2212x1659. Fundus photo — 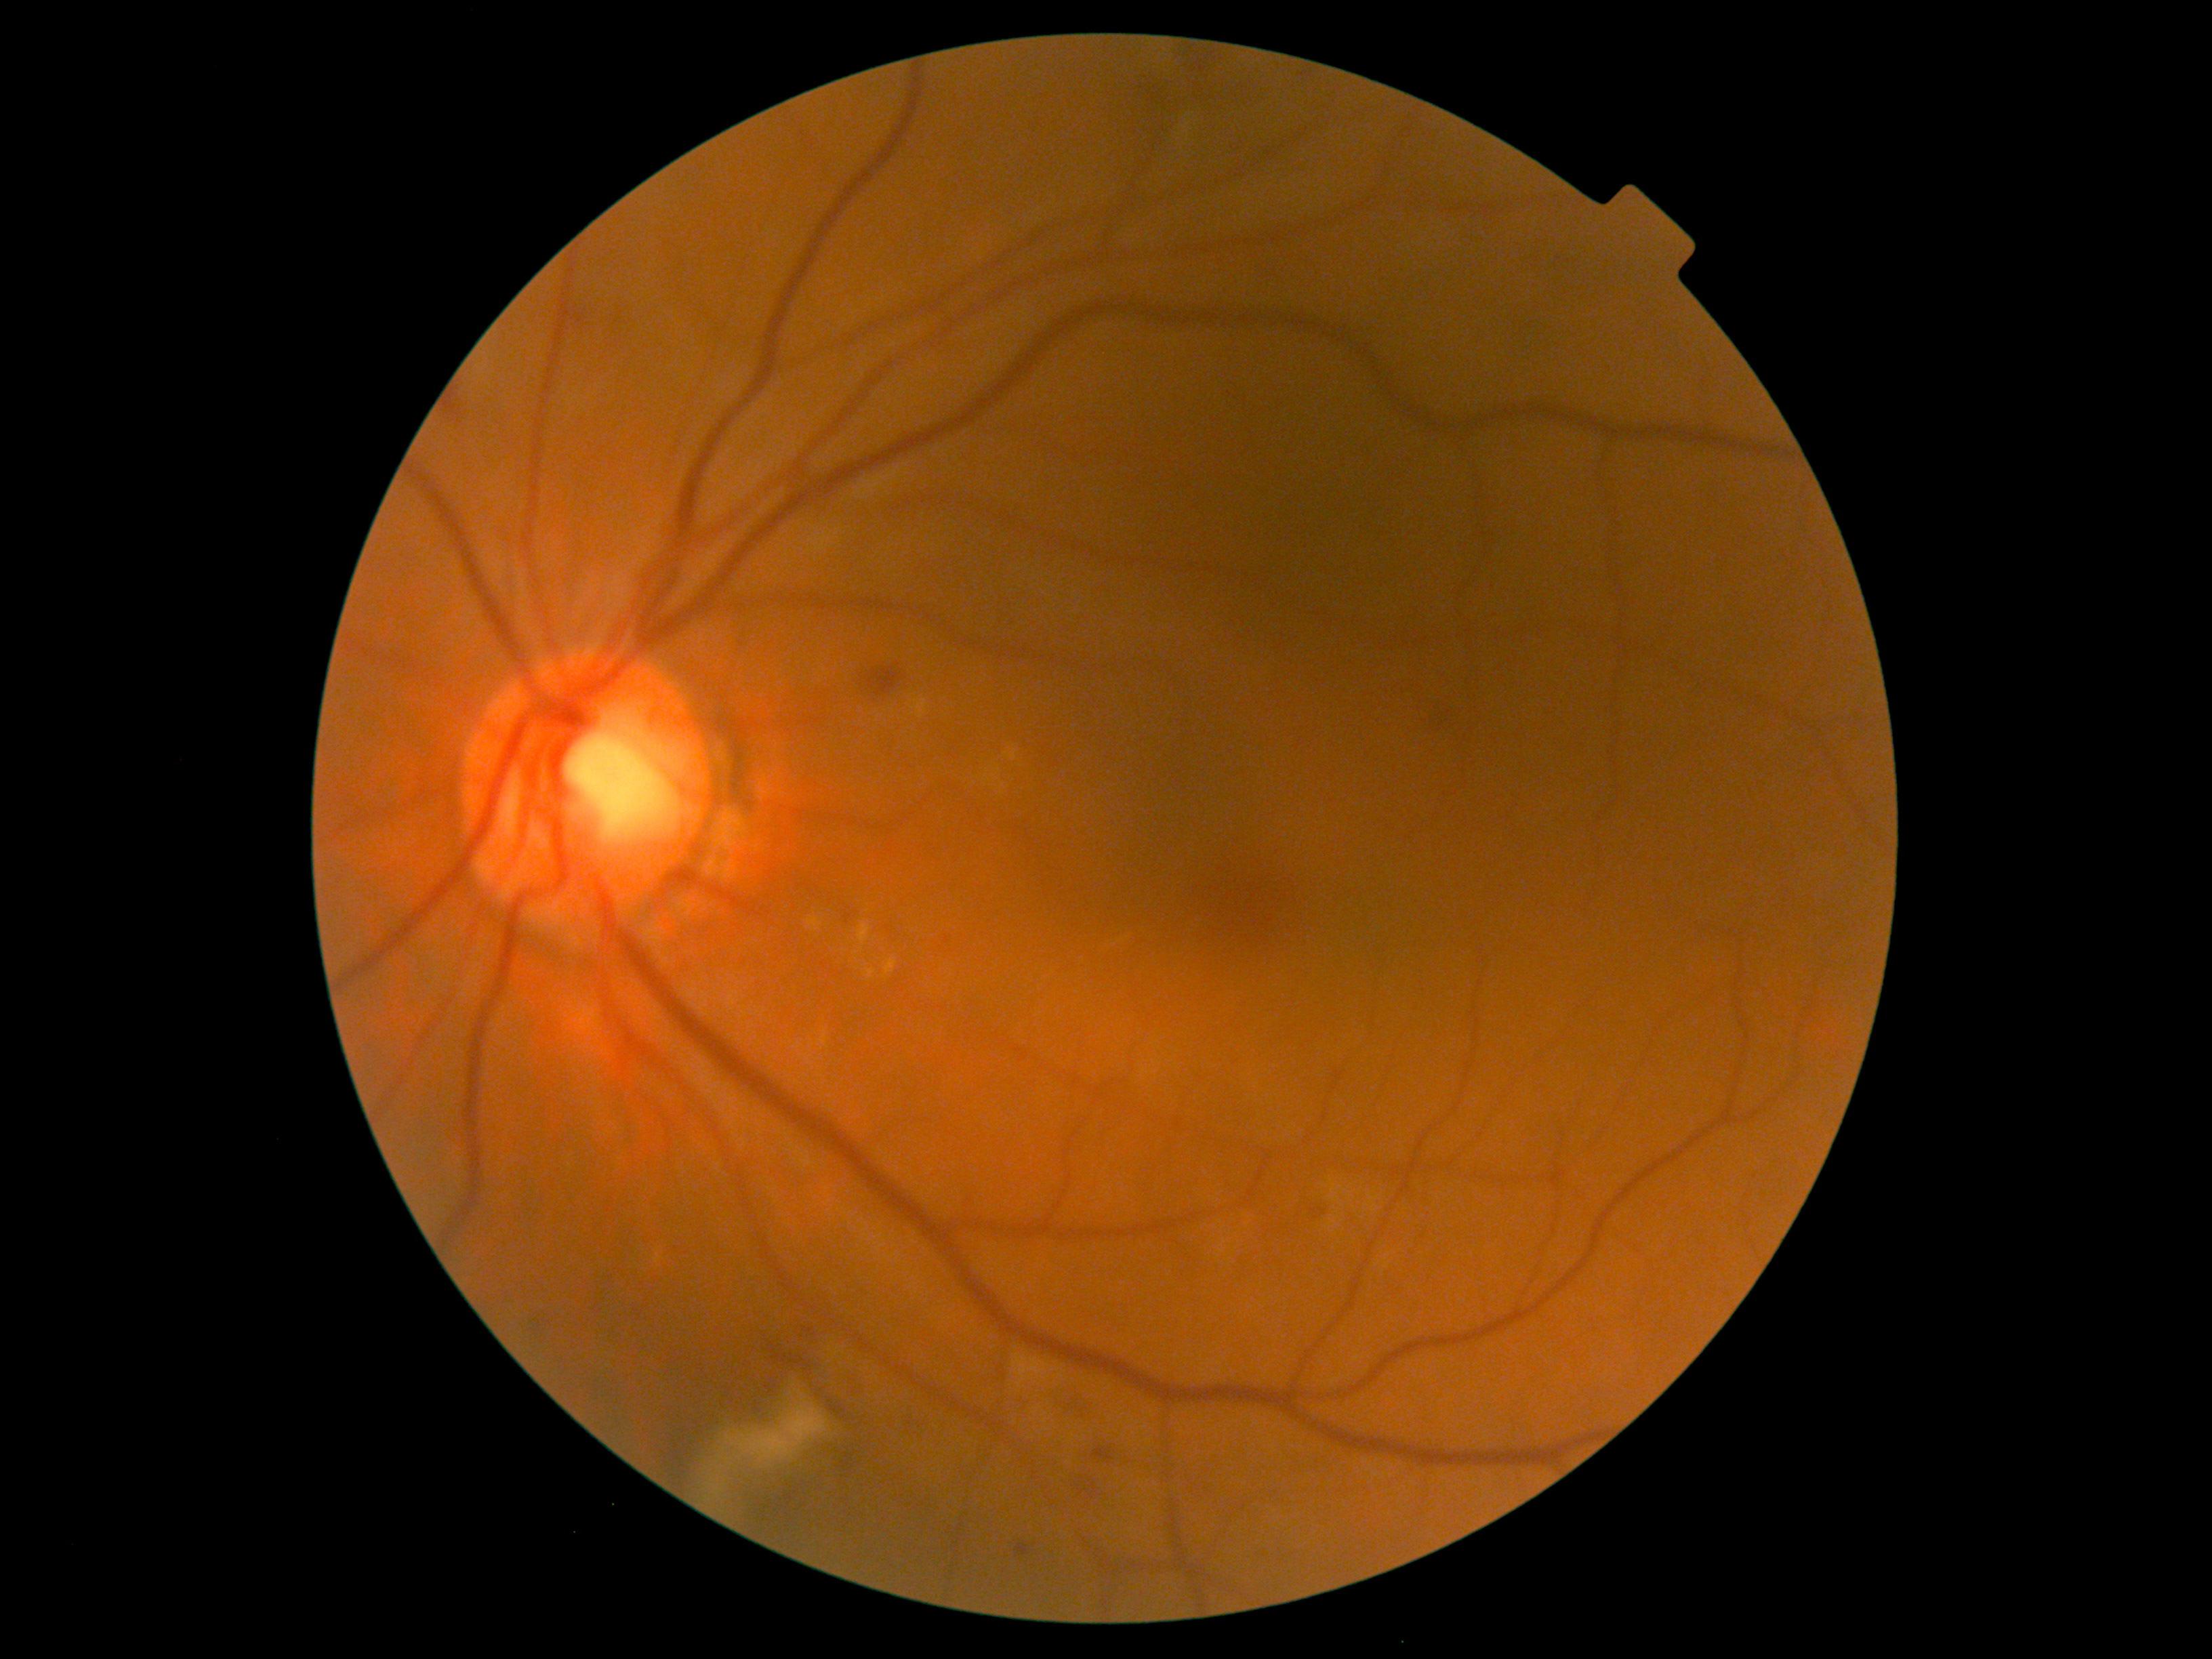
dr_grade: moderate non-proliferative diabetic retinopathy (grade 2)